NIDEK AFC-230:
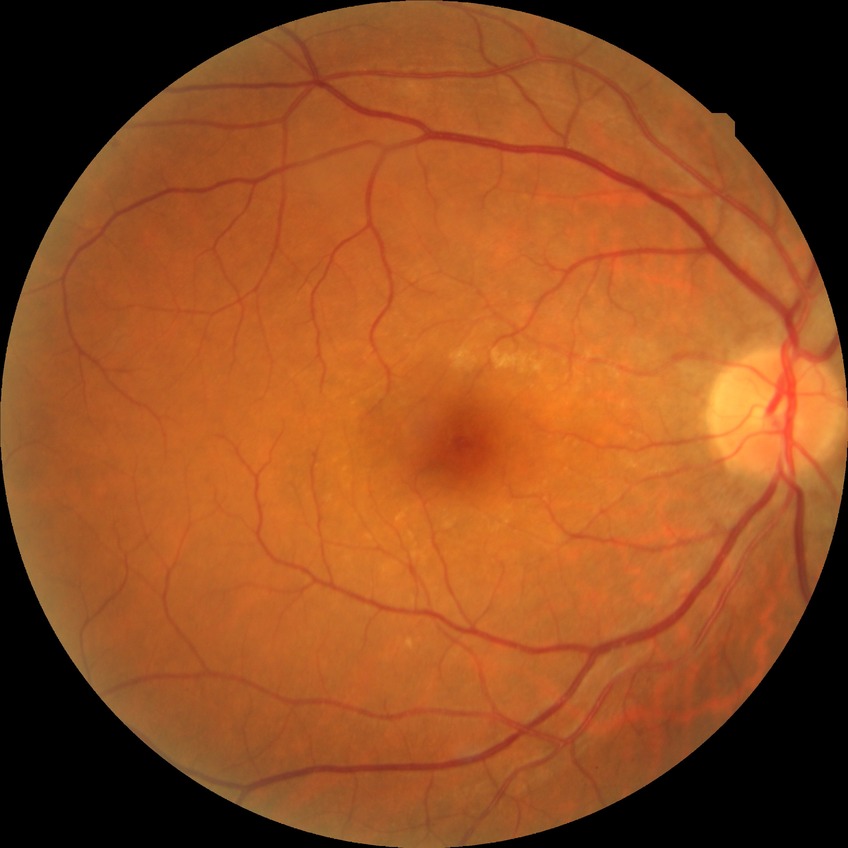 diabetic retinopathy (DR)=no diabetic retinopathy (NDR).